1924x1556px · ultra-widefield fundus photograph:
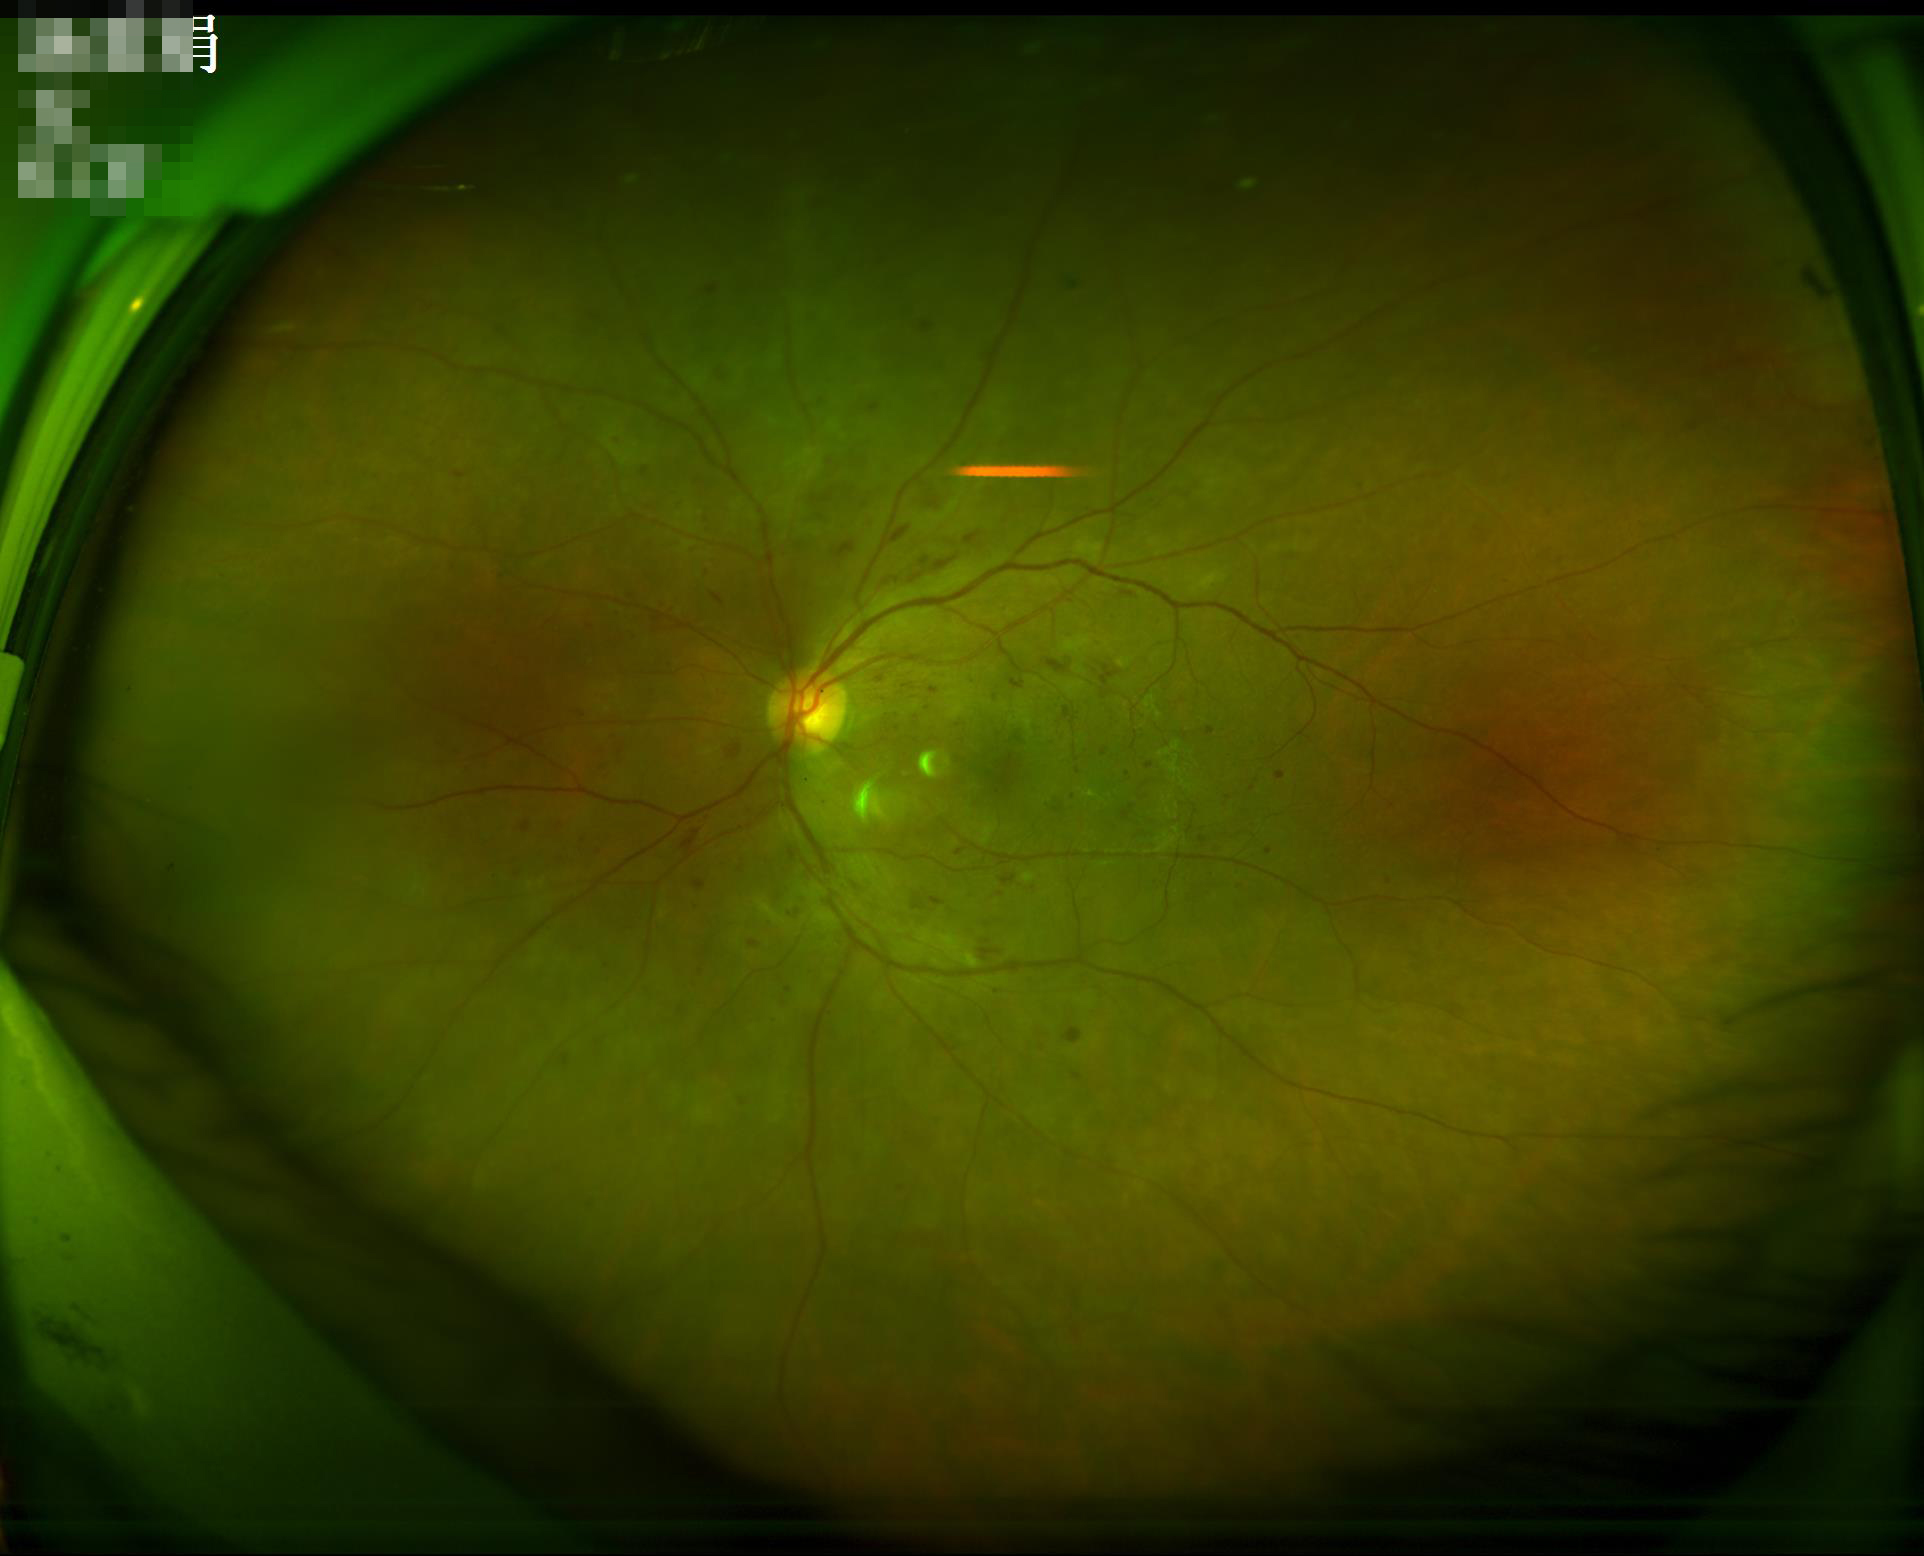 Overall quality is good and the image is gradable. Illumination and color balance are good. Adequate contrast for distinguishing structures.